512 x 512 pixels — 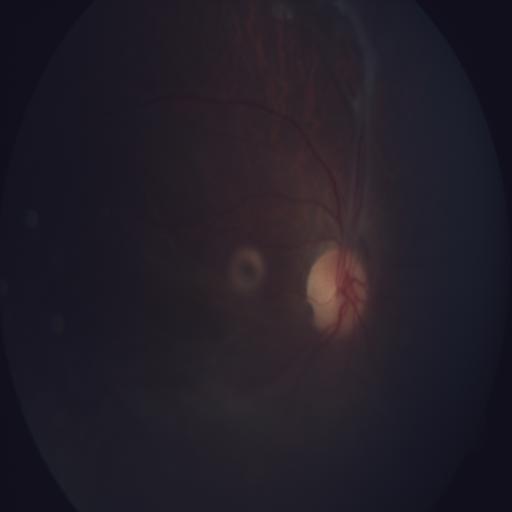
Abnormalities: RT (retinal traction).